Color fundus photograph.
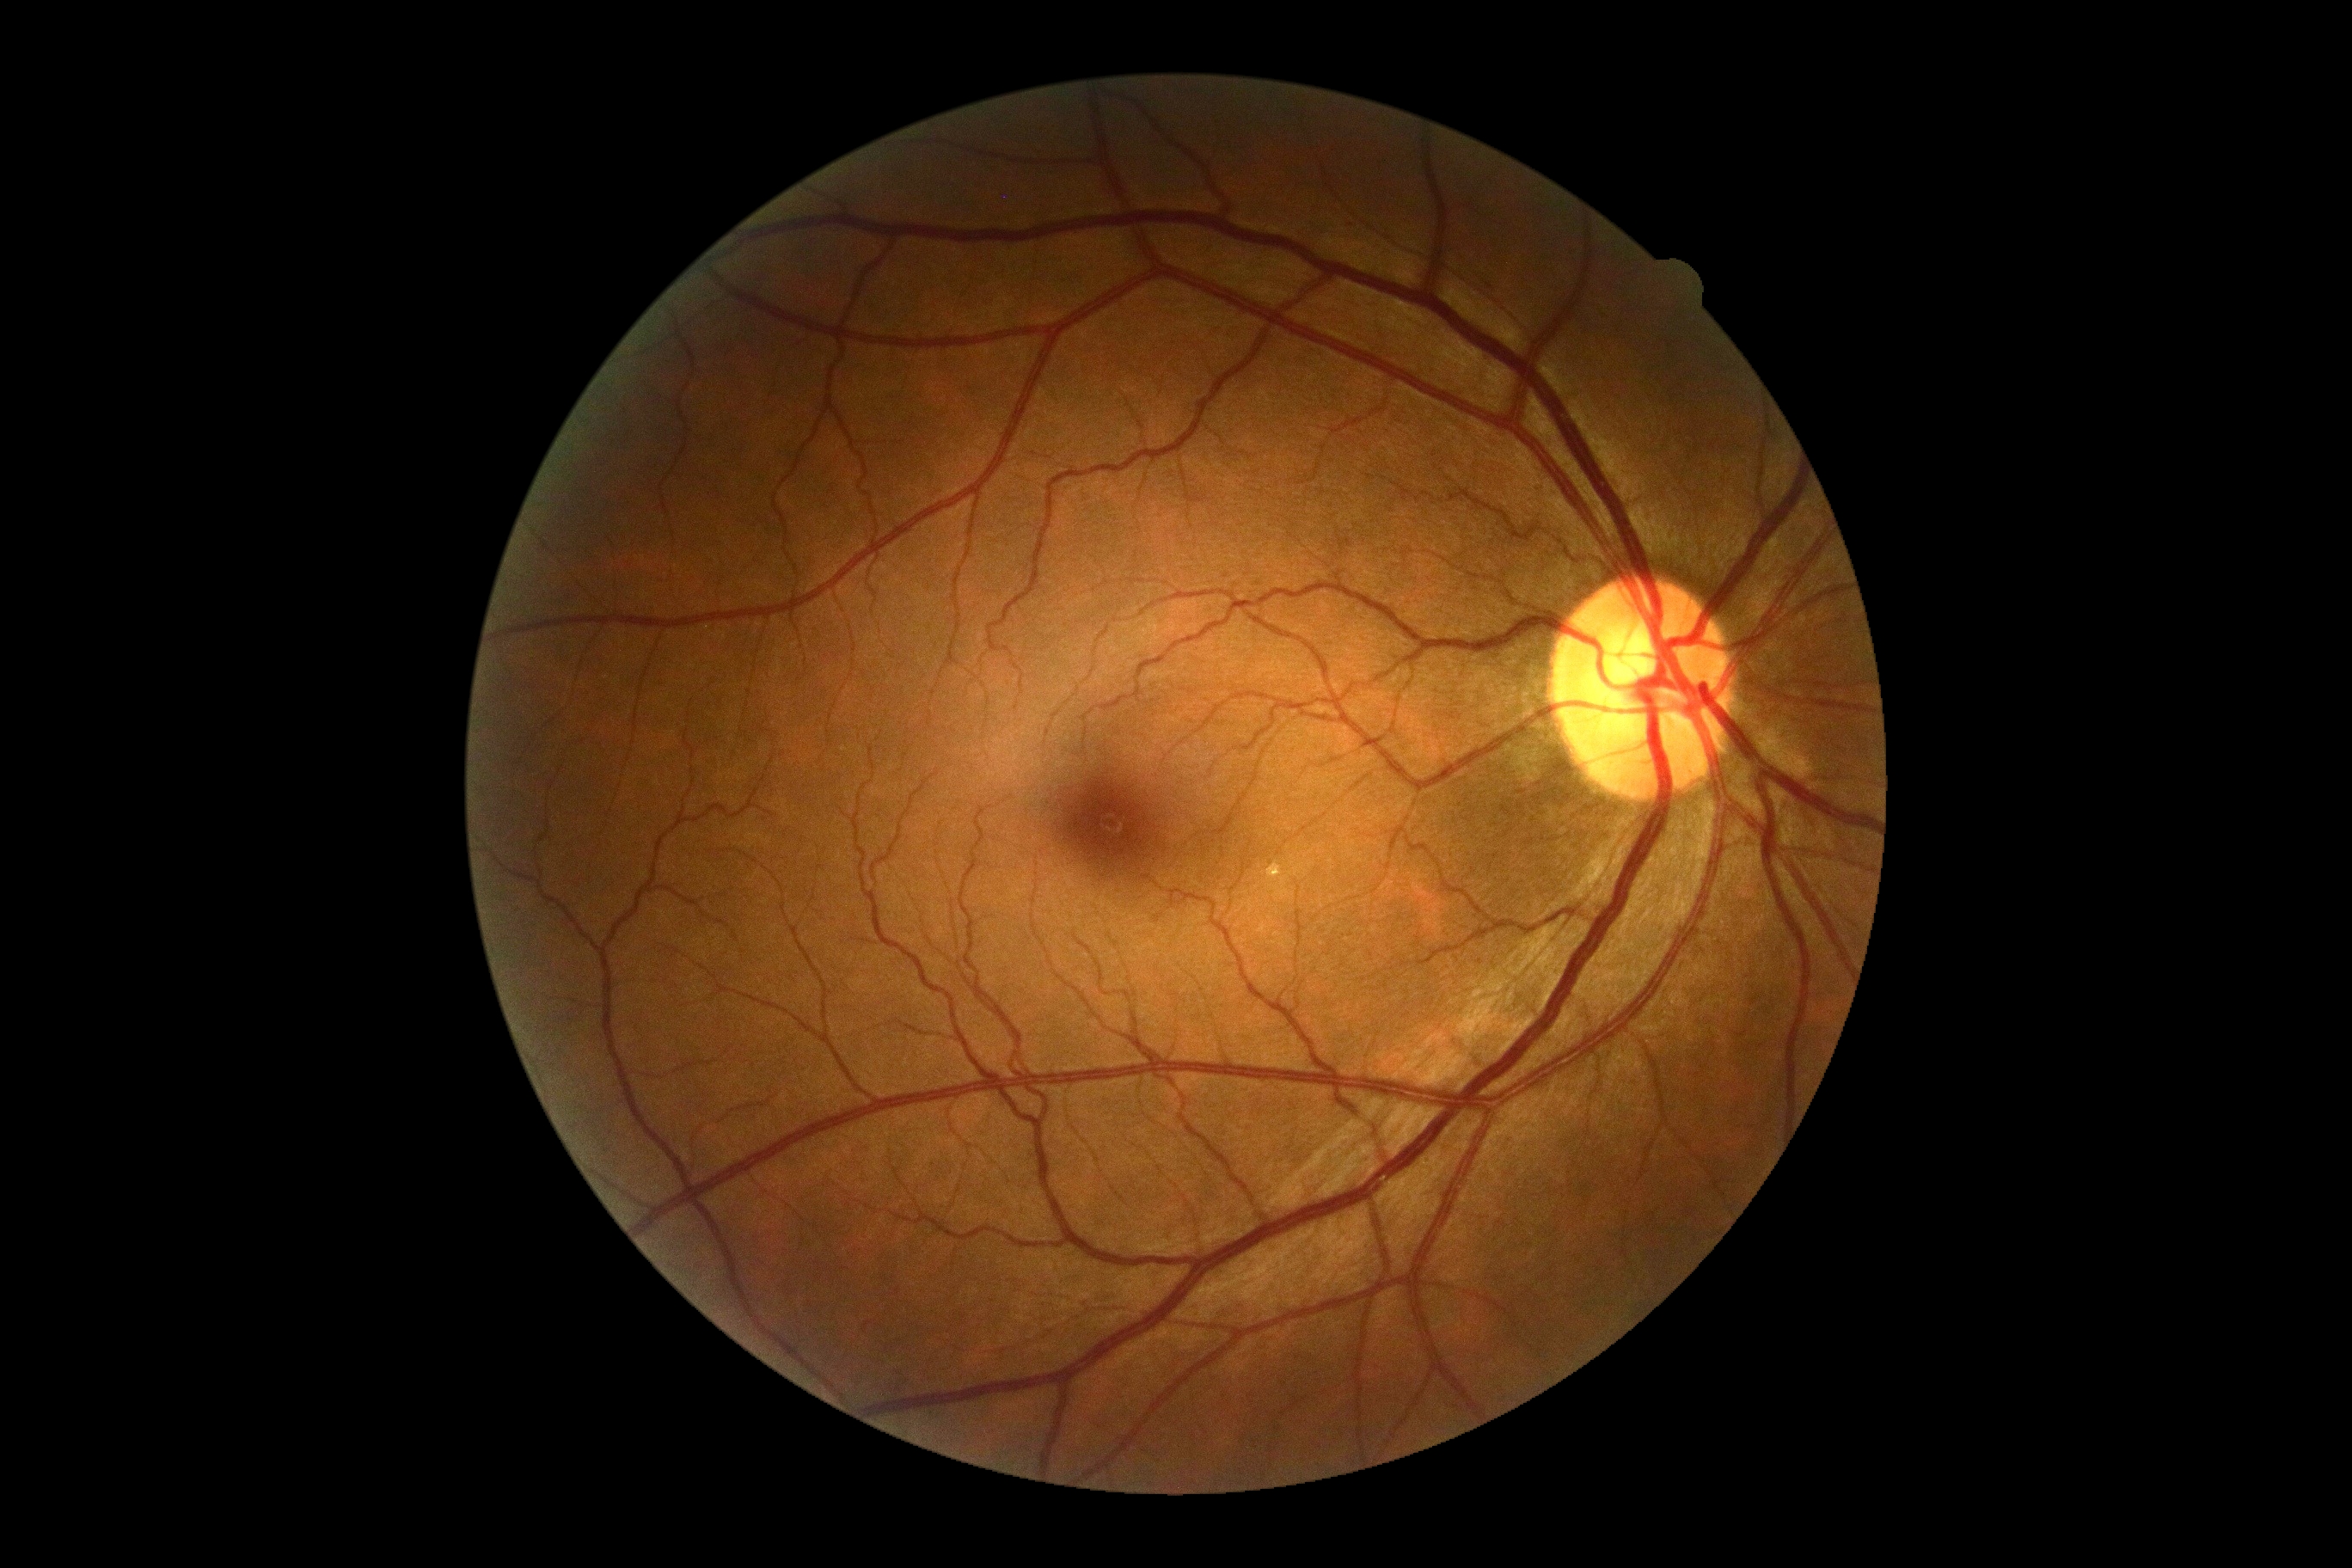

DR is no apparent retinopathy (grade 0) — no visible signs of diabetic retinopathy.